45-degree field of view; 2352x1568px
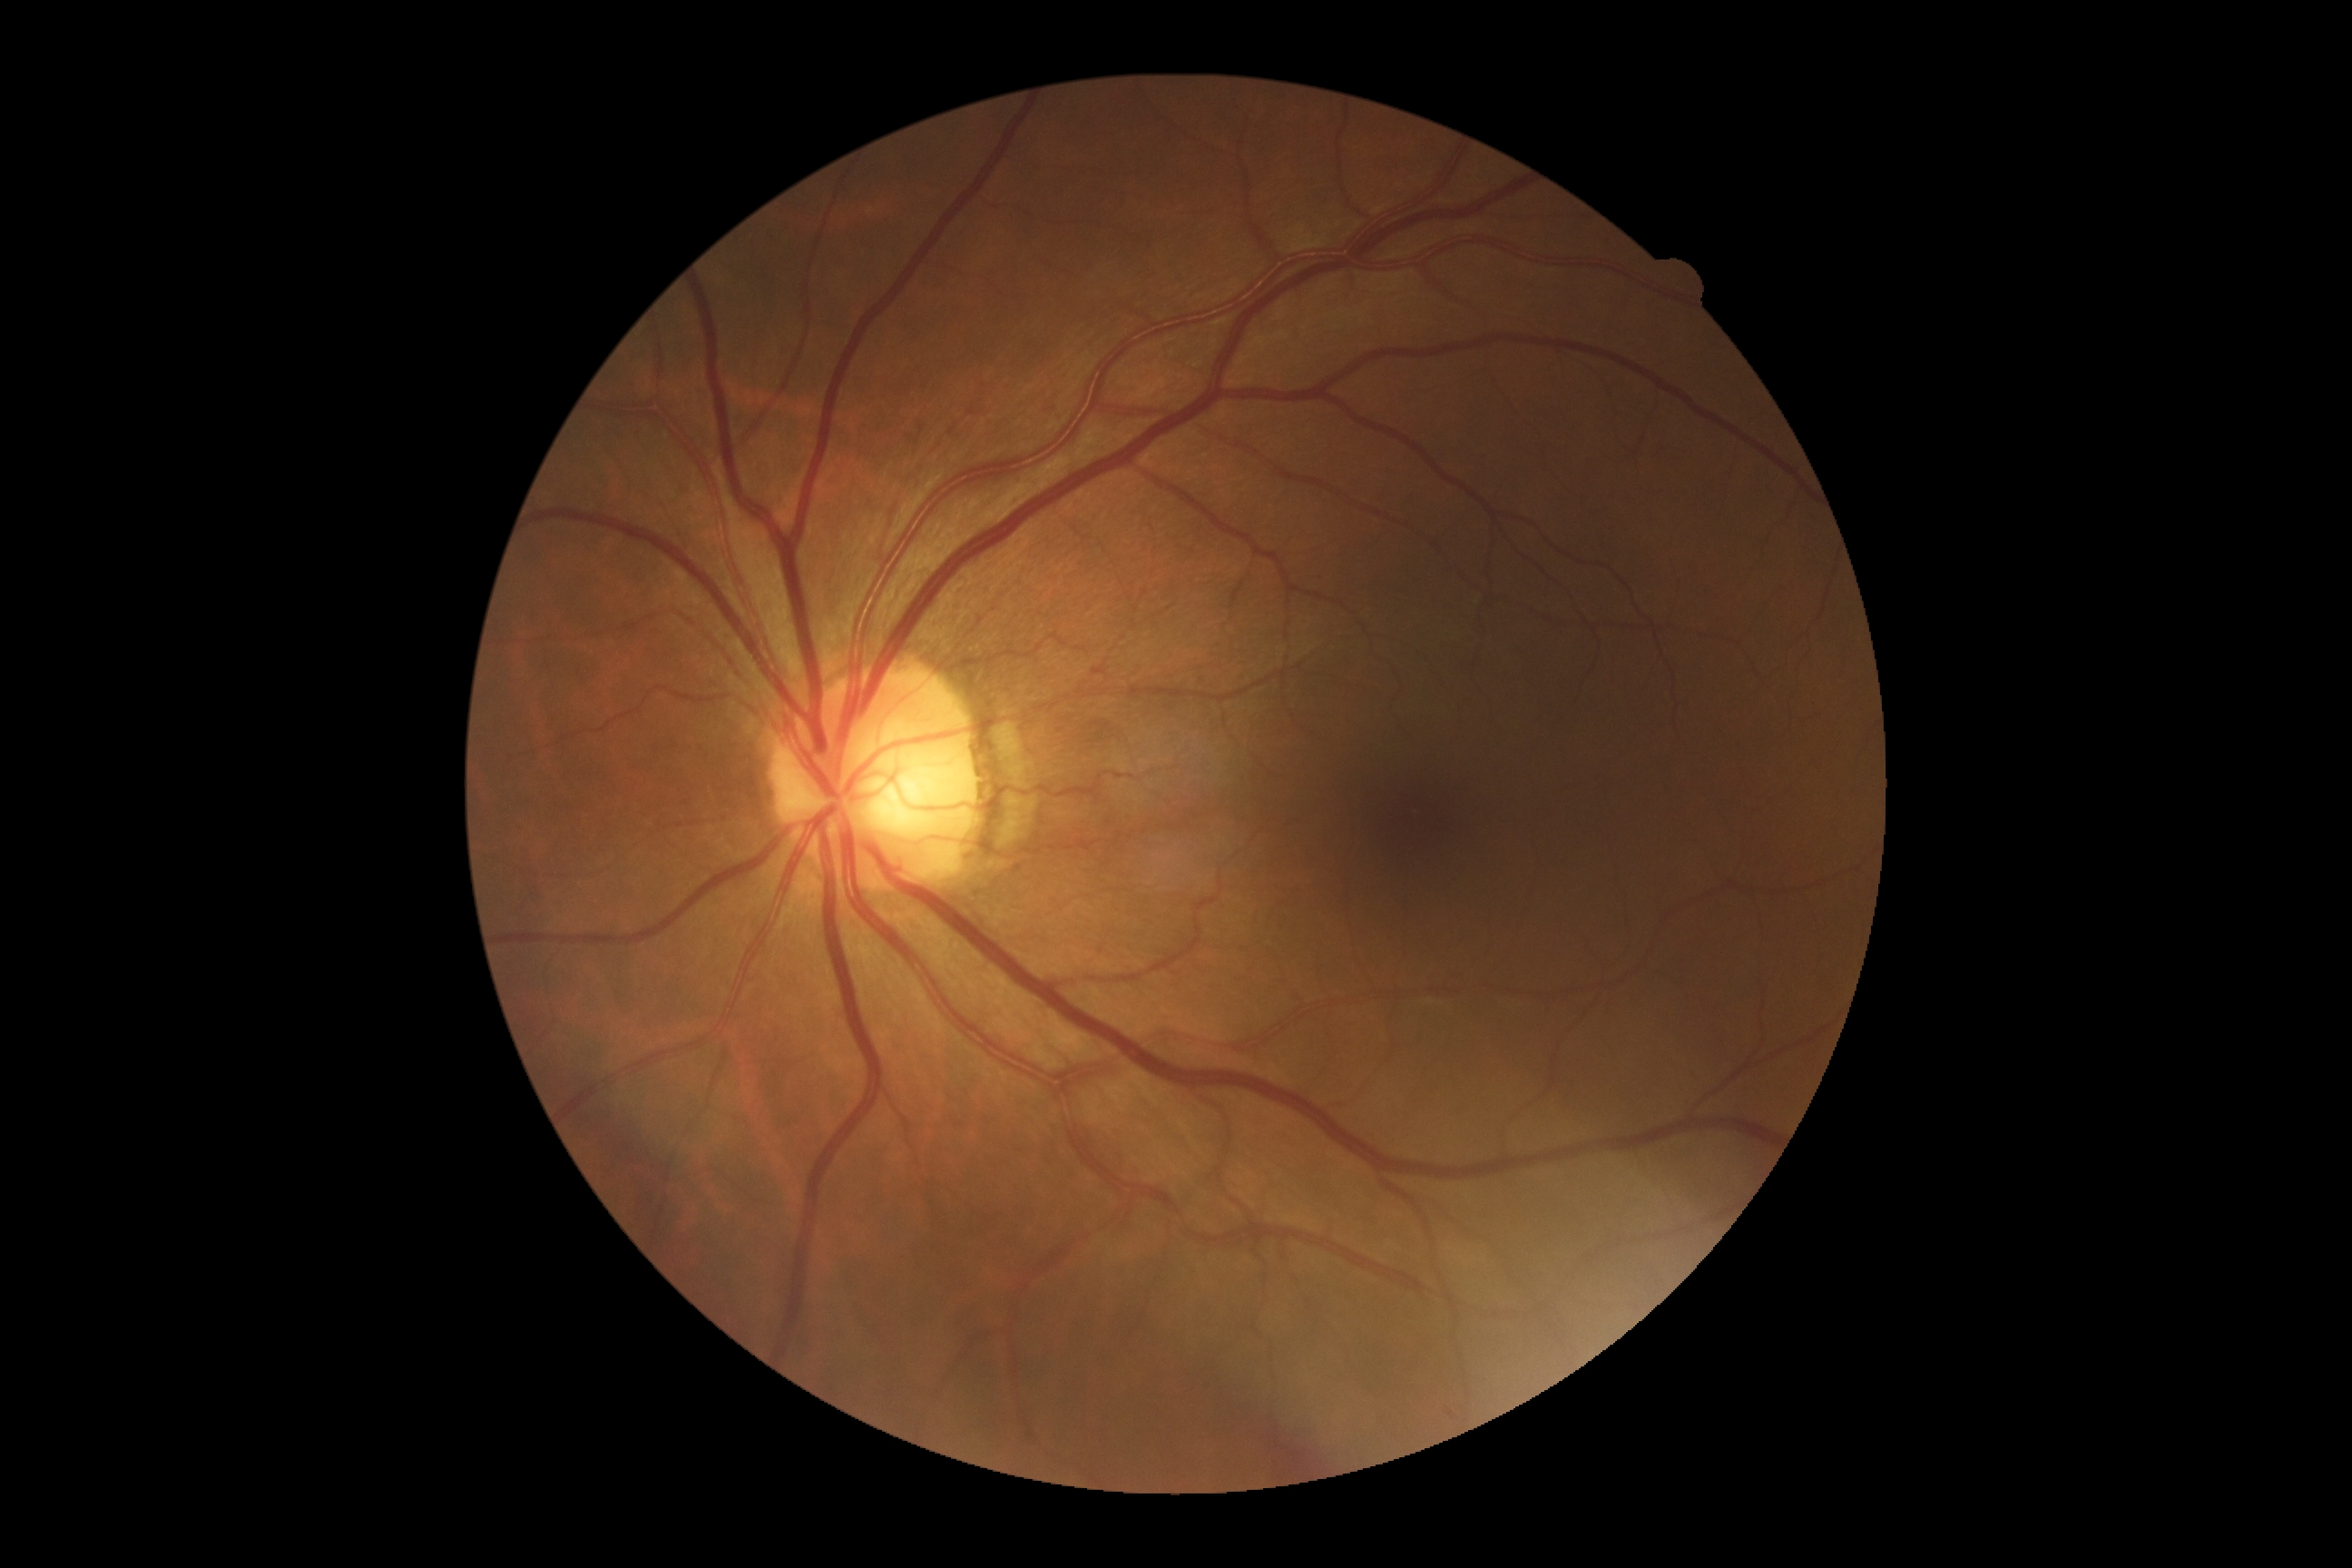 DR grade: 0 (no apparent retinopathy).